2228x1652px, 50° FOV, captured on a Topcon TRC-50DX fundus camera.
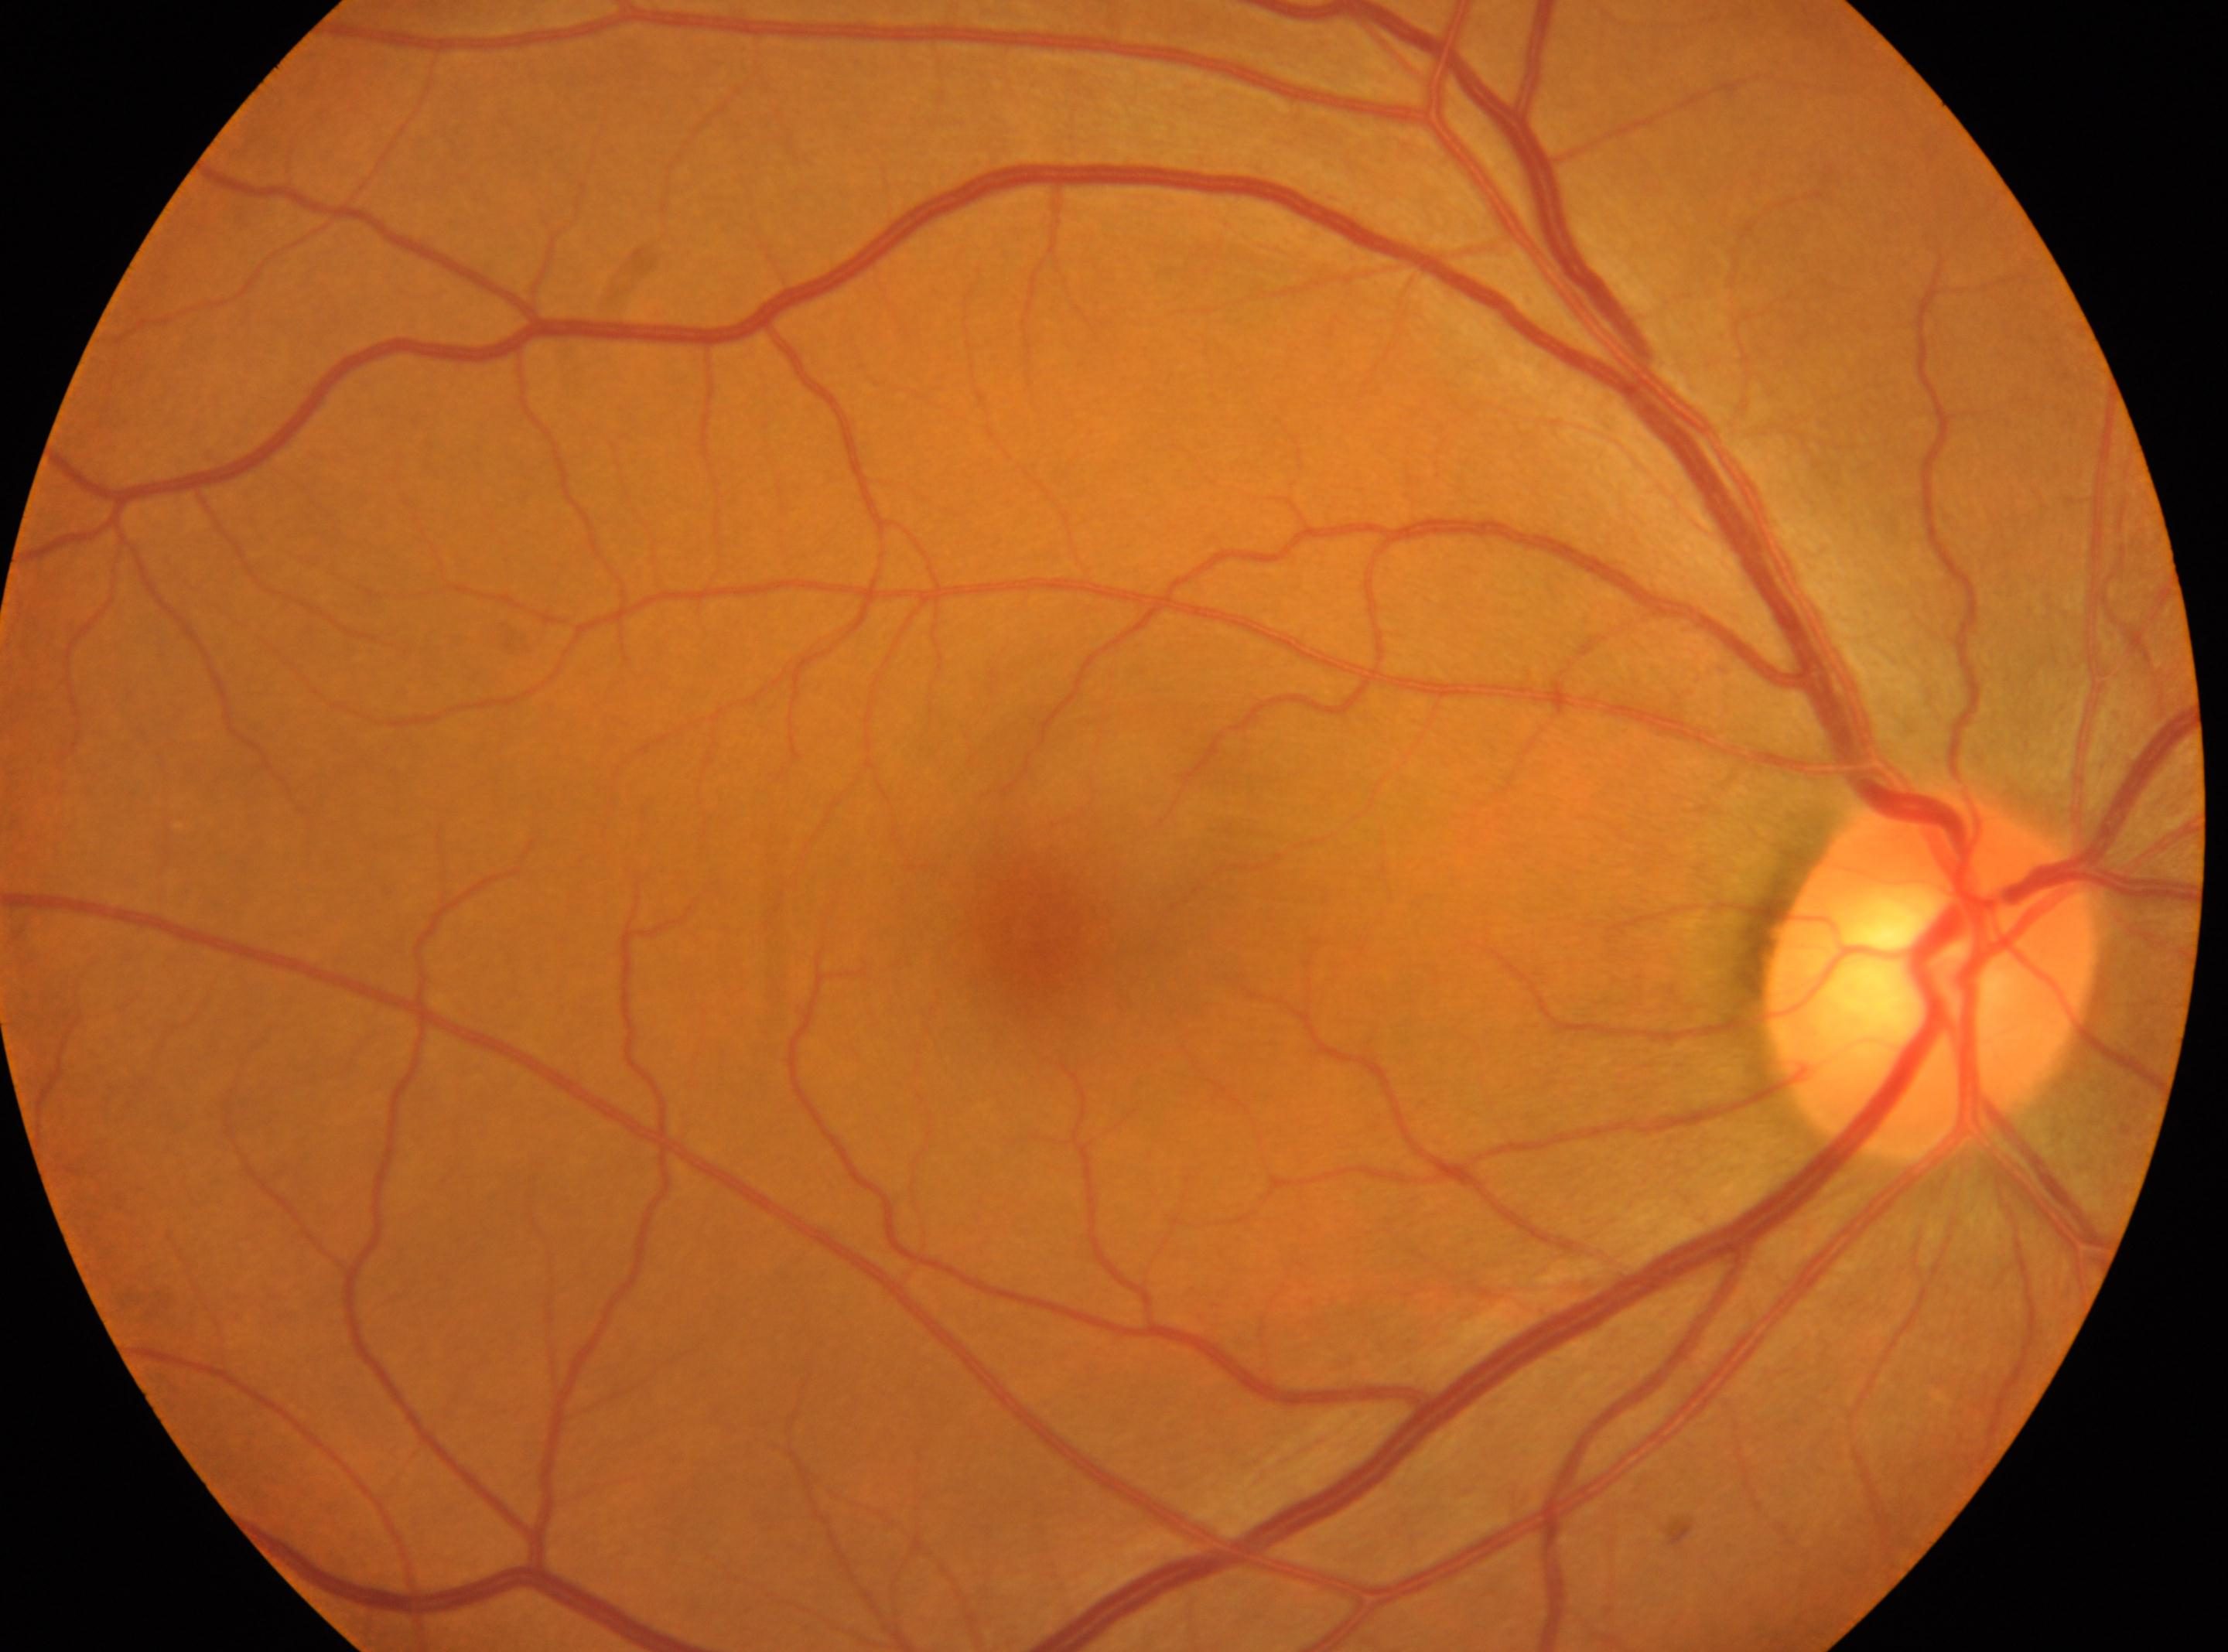
laterality: right; fovea centralis: (x: 1037, y: 923); DR stage: grade 0 (no apparent retinopathy); optic disc: (x: 1931, y: 978); DR impression: No diabetic retinal disease findings.